45° field of view — 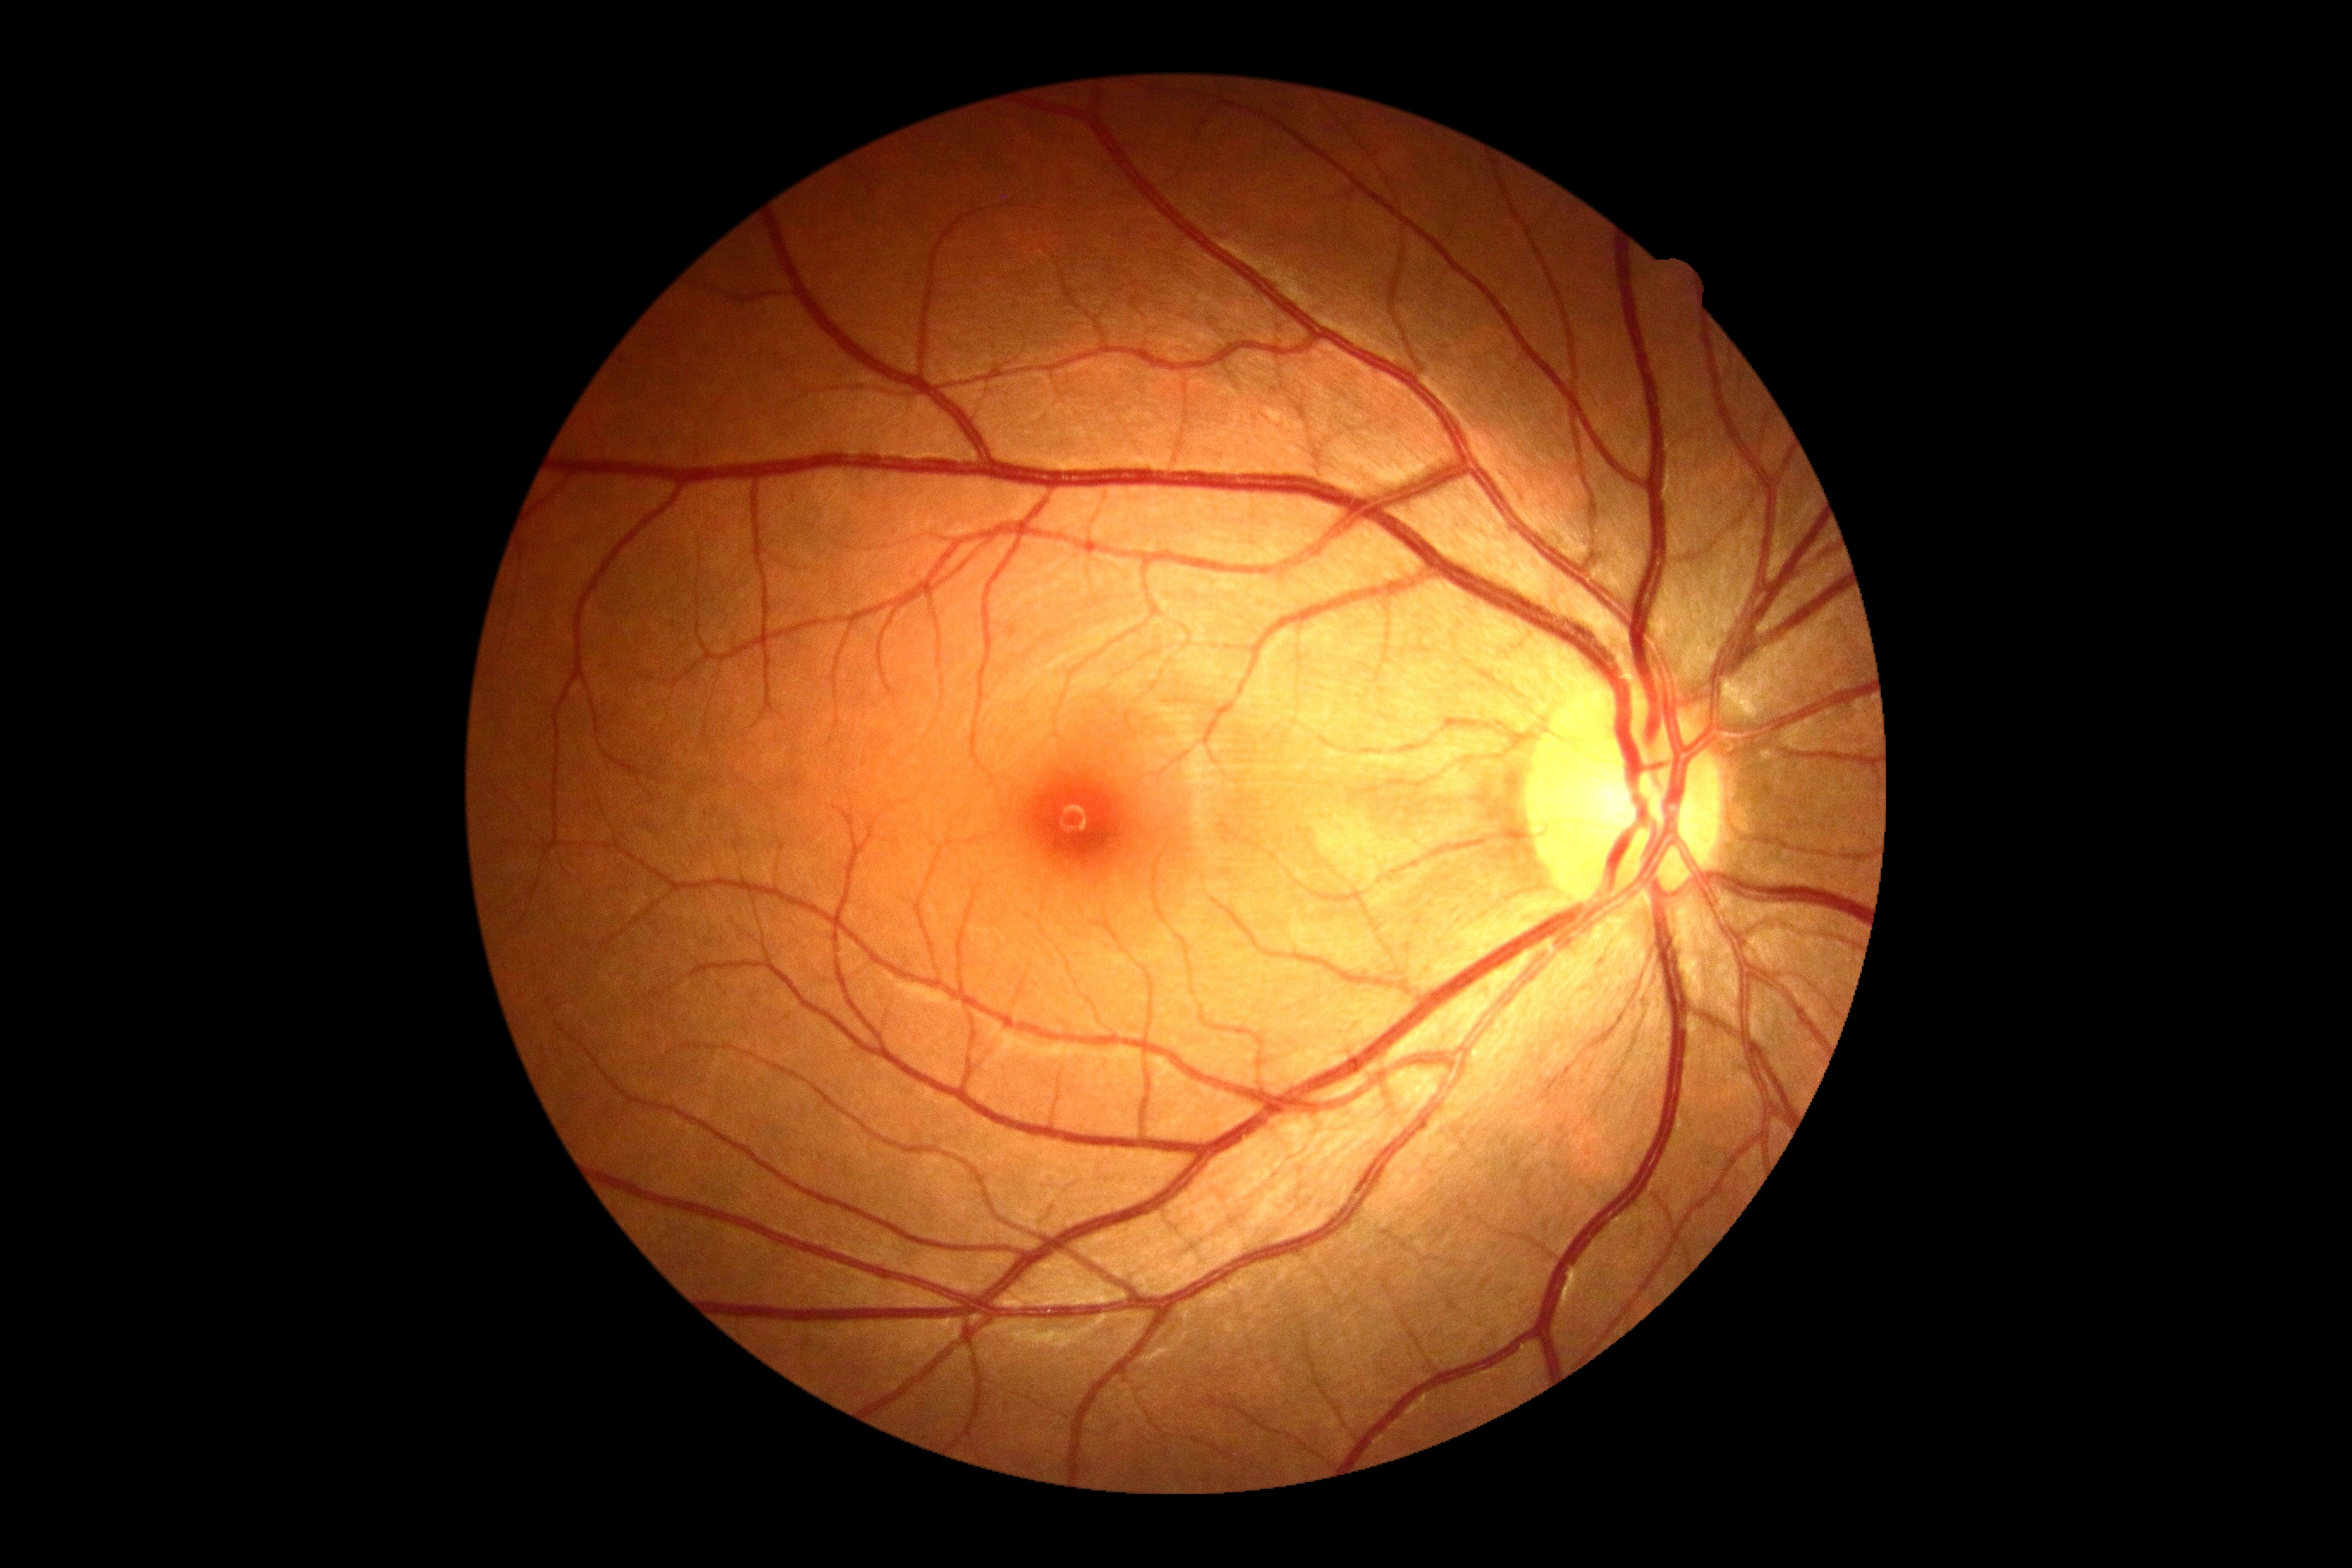
Annotations:
– DR severity — grade 0